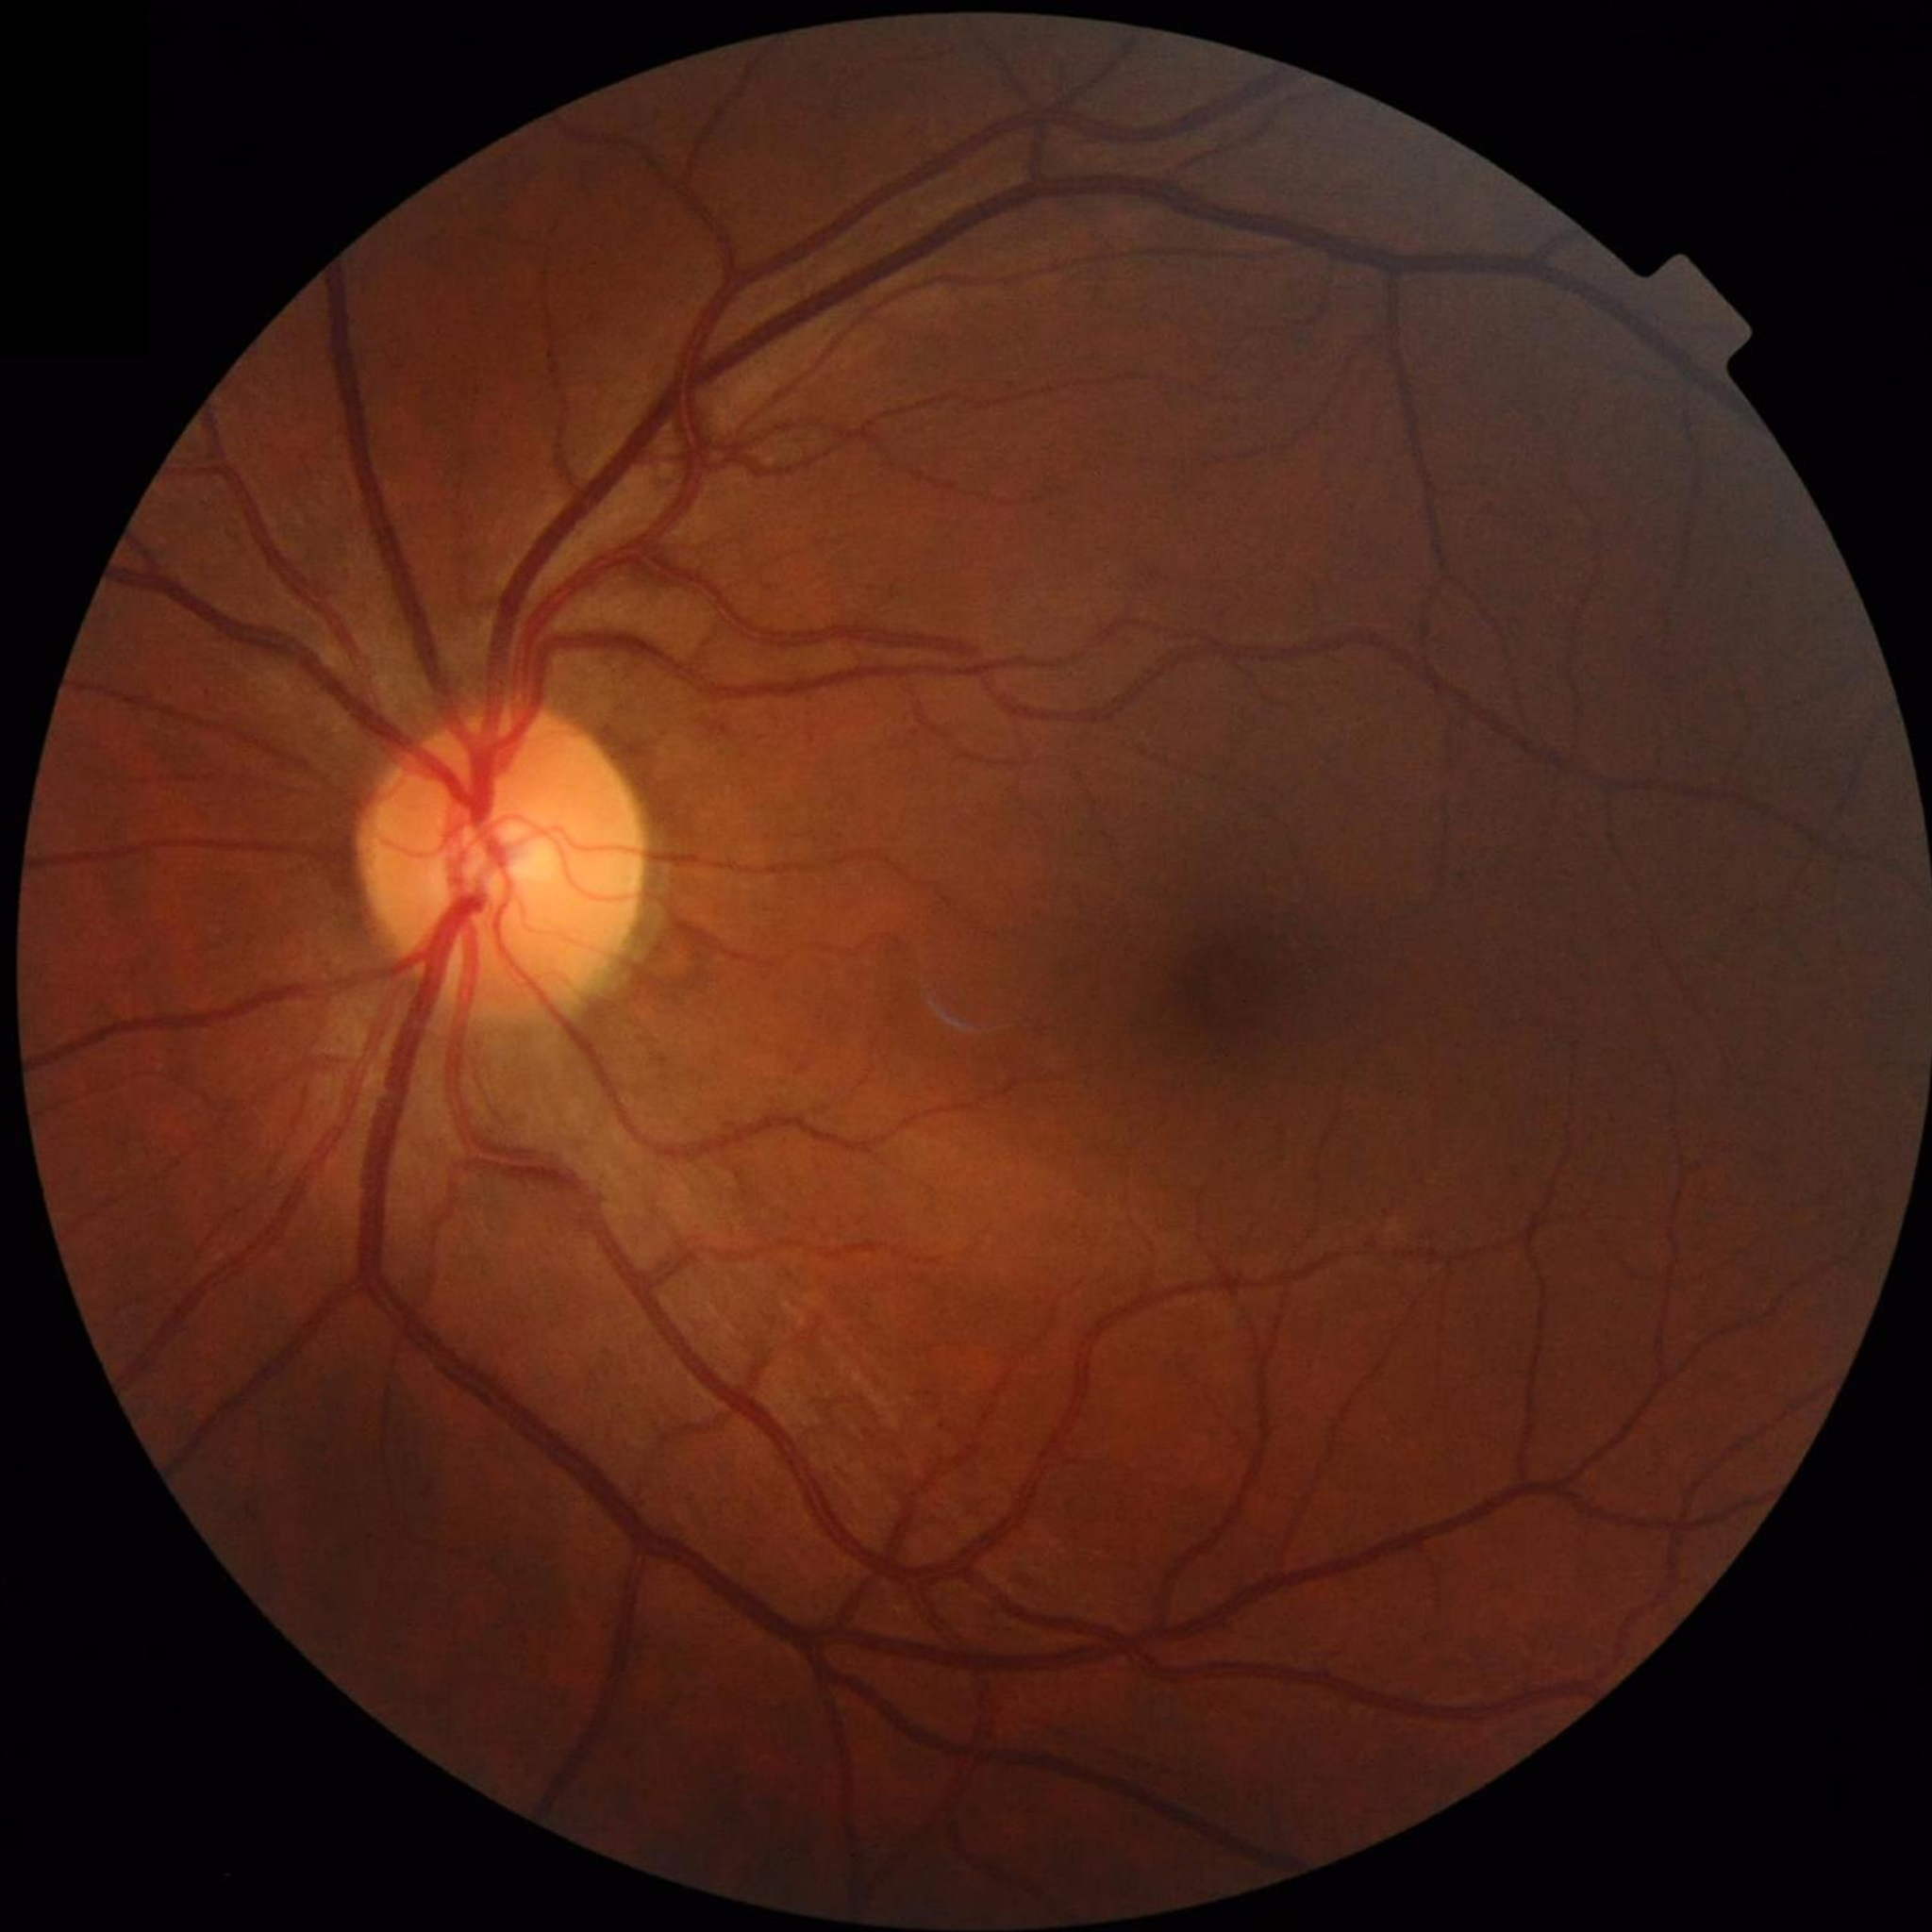

Diagnosis: control (no AMD/DR/glaucoma) | Photo quality: good.